Captured with the Phoenix ICON (100° field of view). Wide-field contact fundus photograph of an infant:
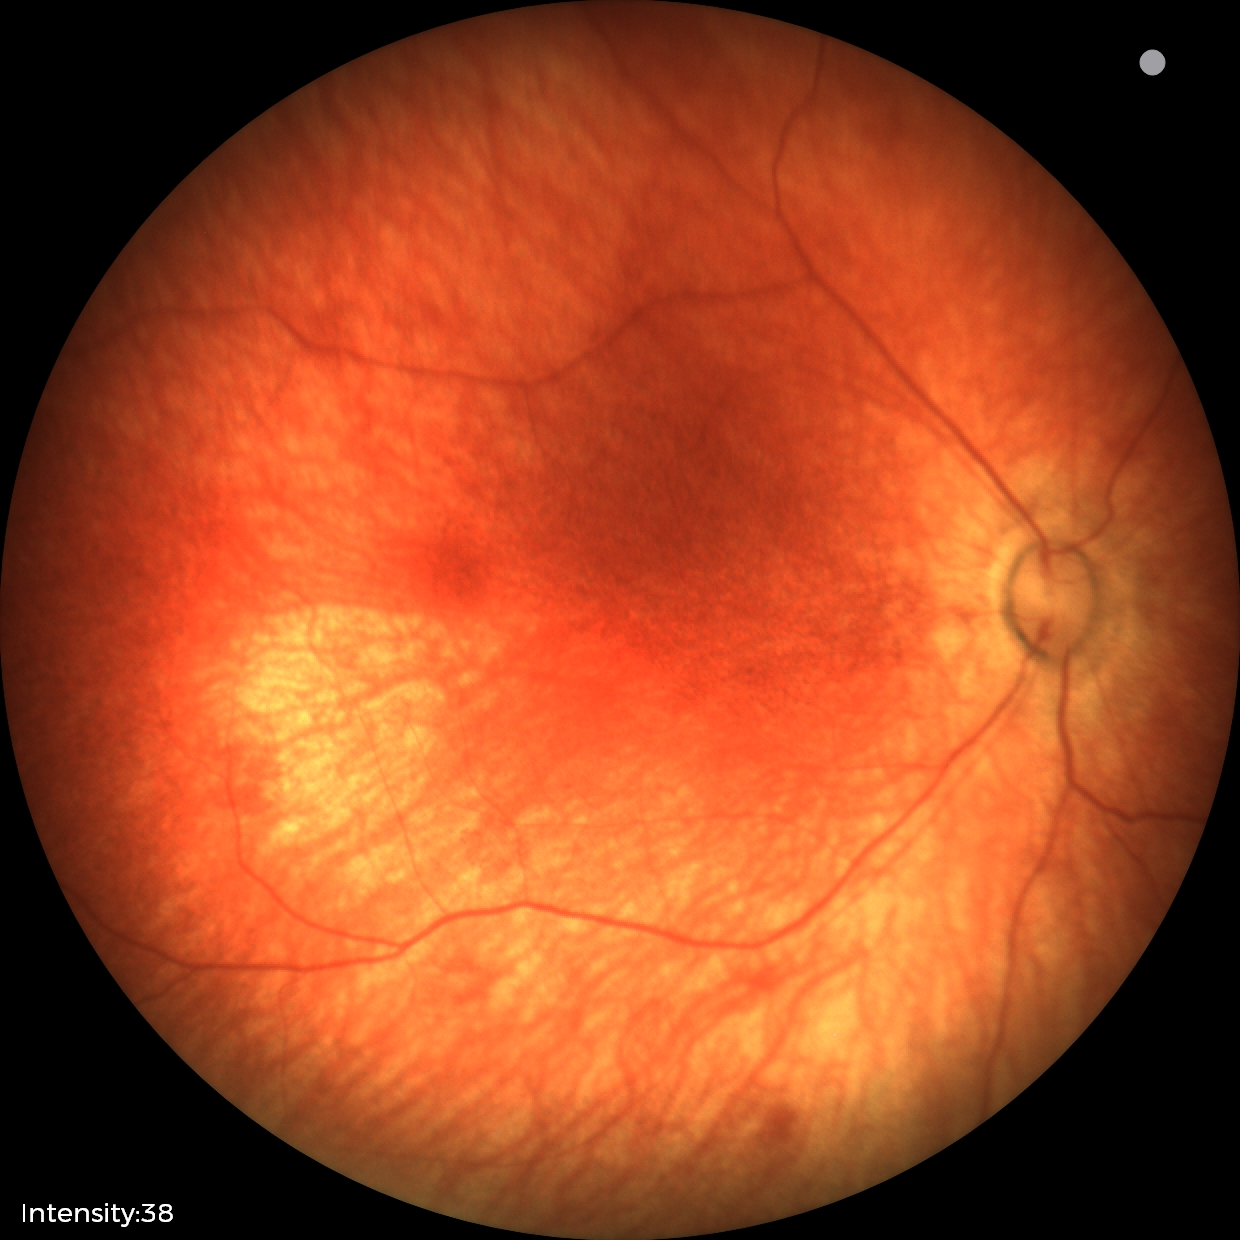
Impression = physiological appearance